45-degree field of view · nonmydriatic fundus photograph · 848 x 848 pixels · diabetic retinopathy graded by the modified Davis classification.
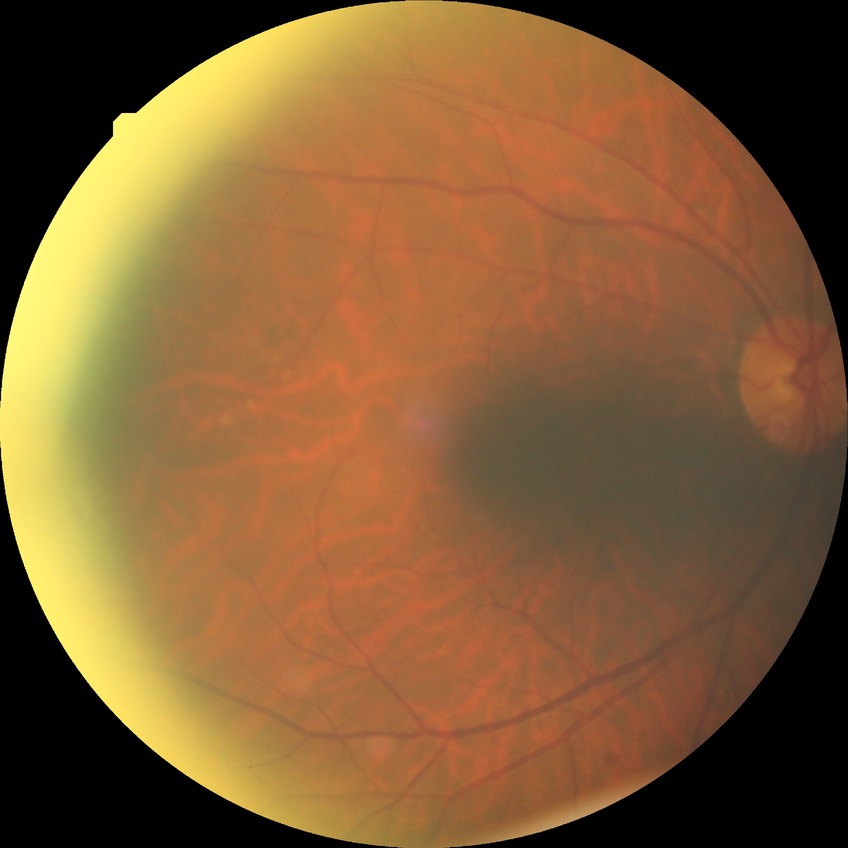

Diabetic retinopathy (DR) is SDR (simple diabetic retinopathy). The retinopathy is classified as non-proliferative diabetic retinopathy.